45° FOV:
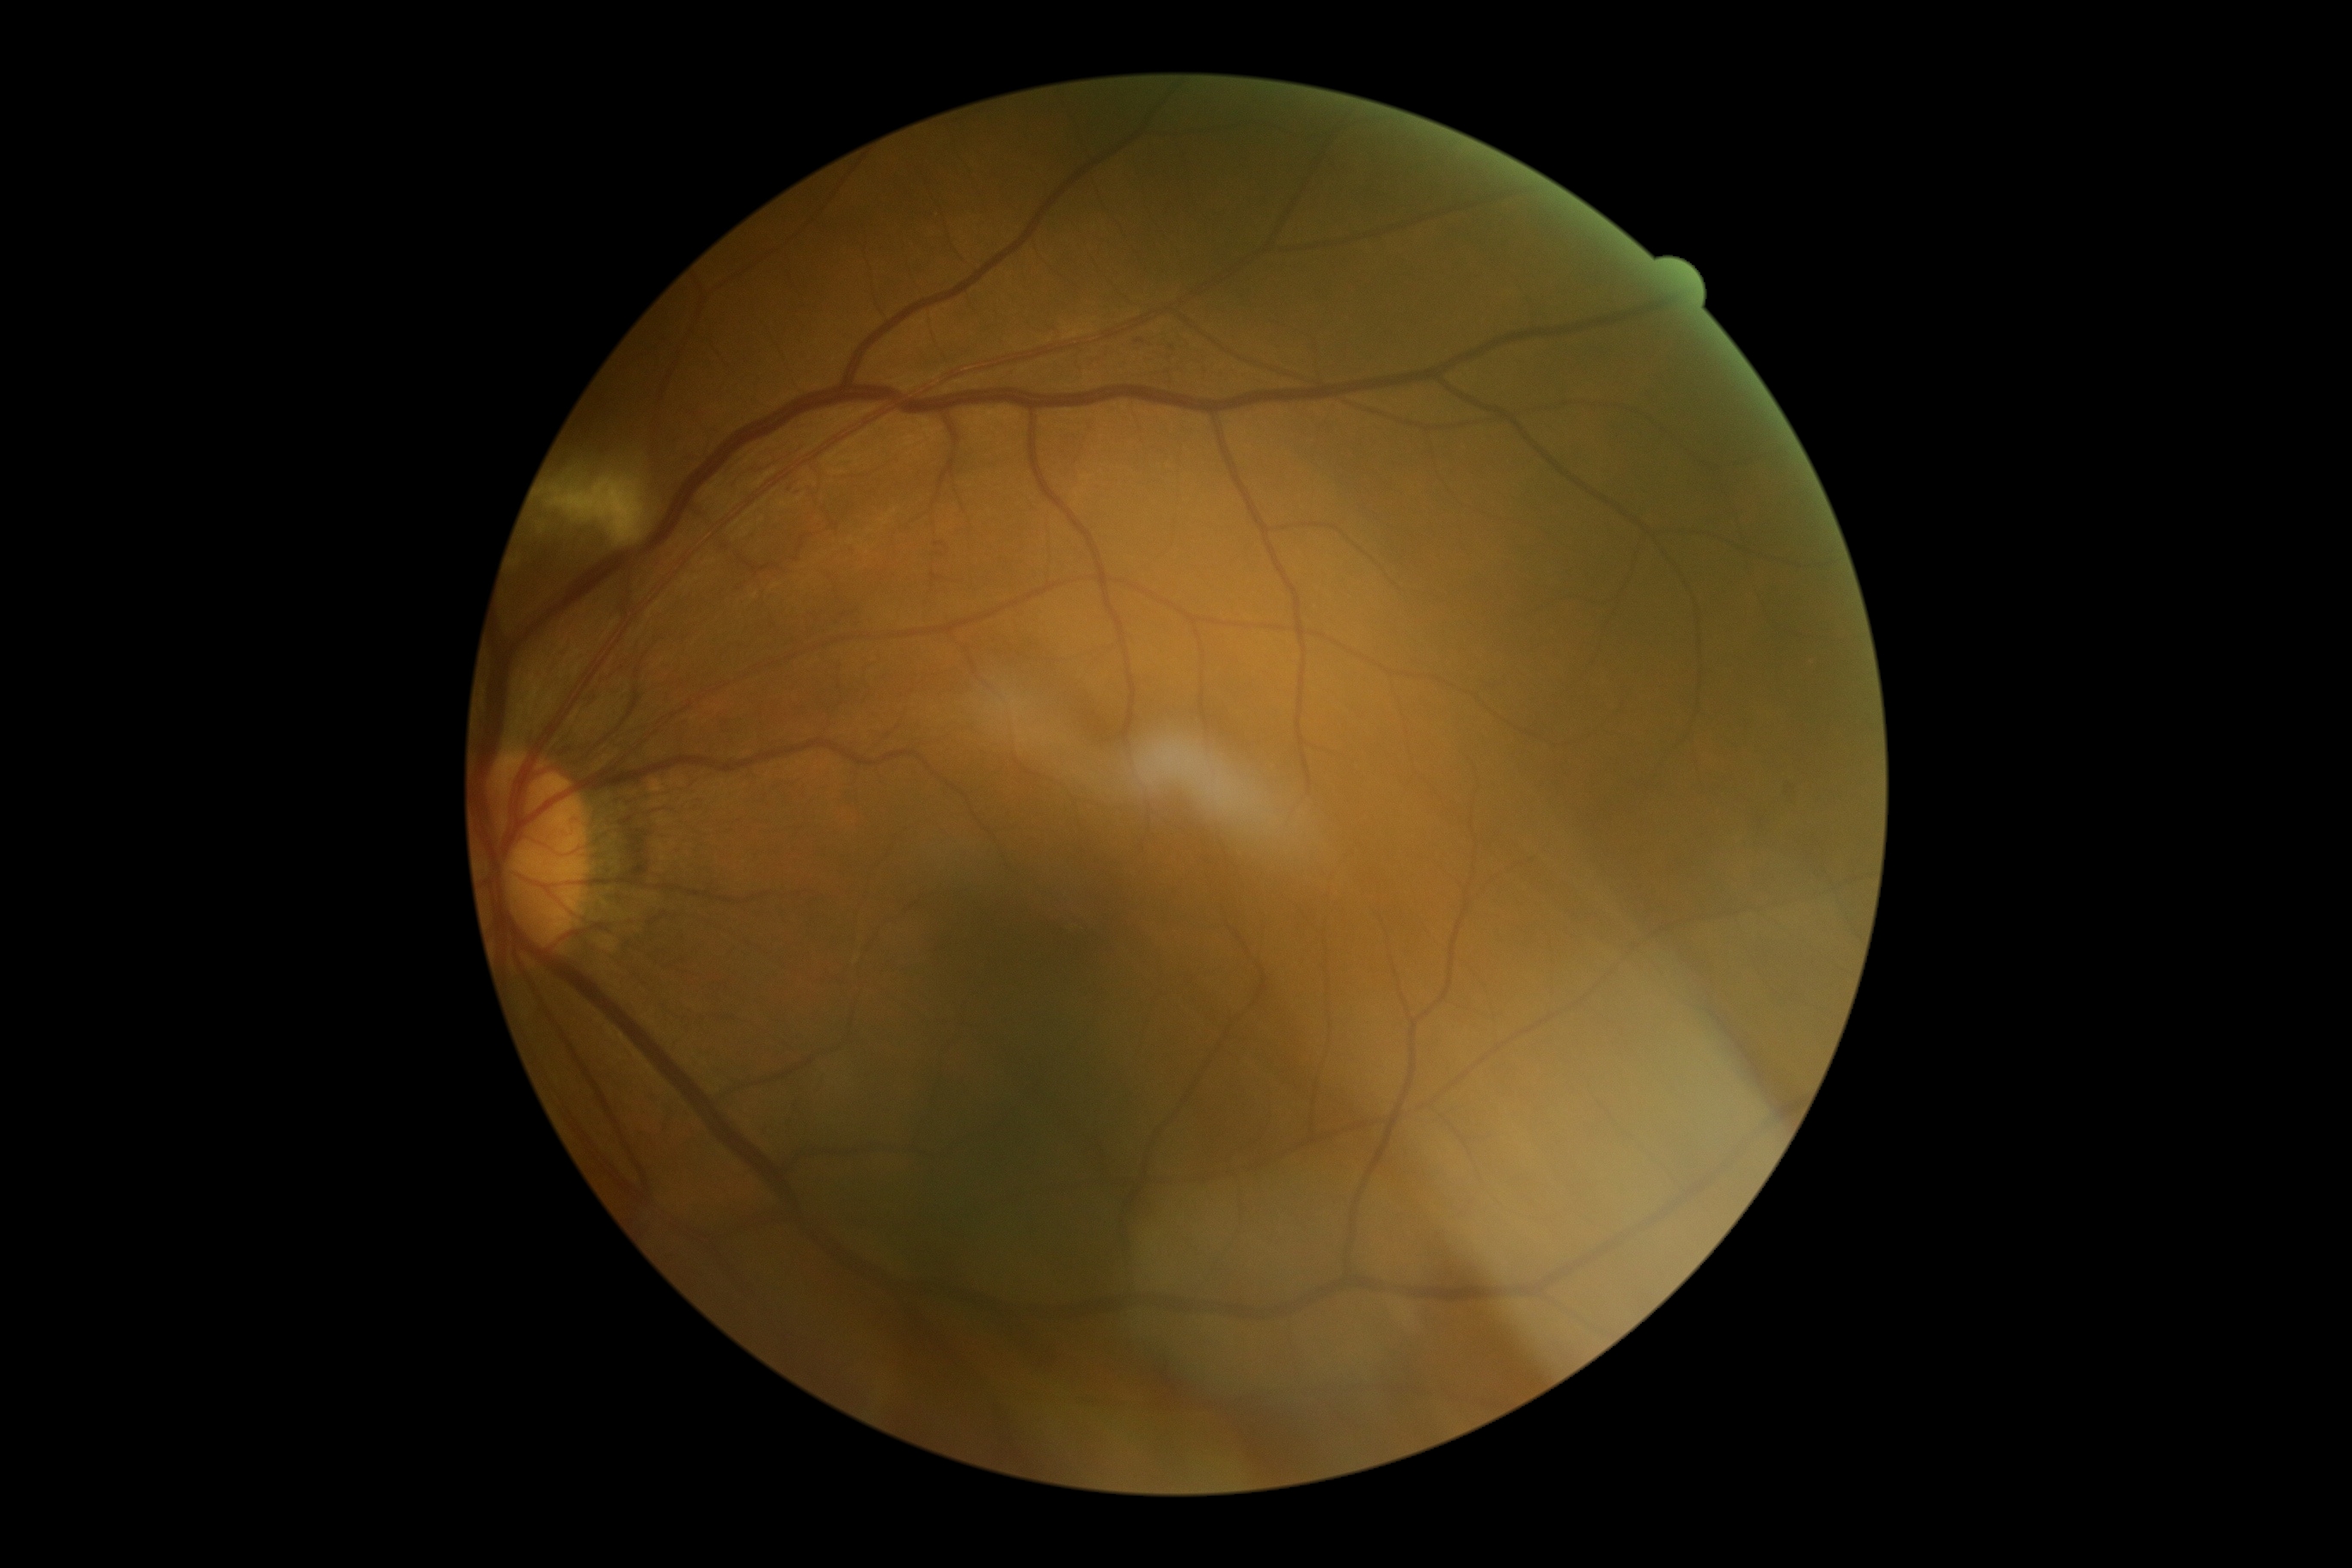
DR stage: moderate NPDR (grade 2).